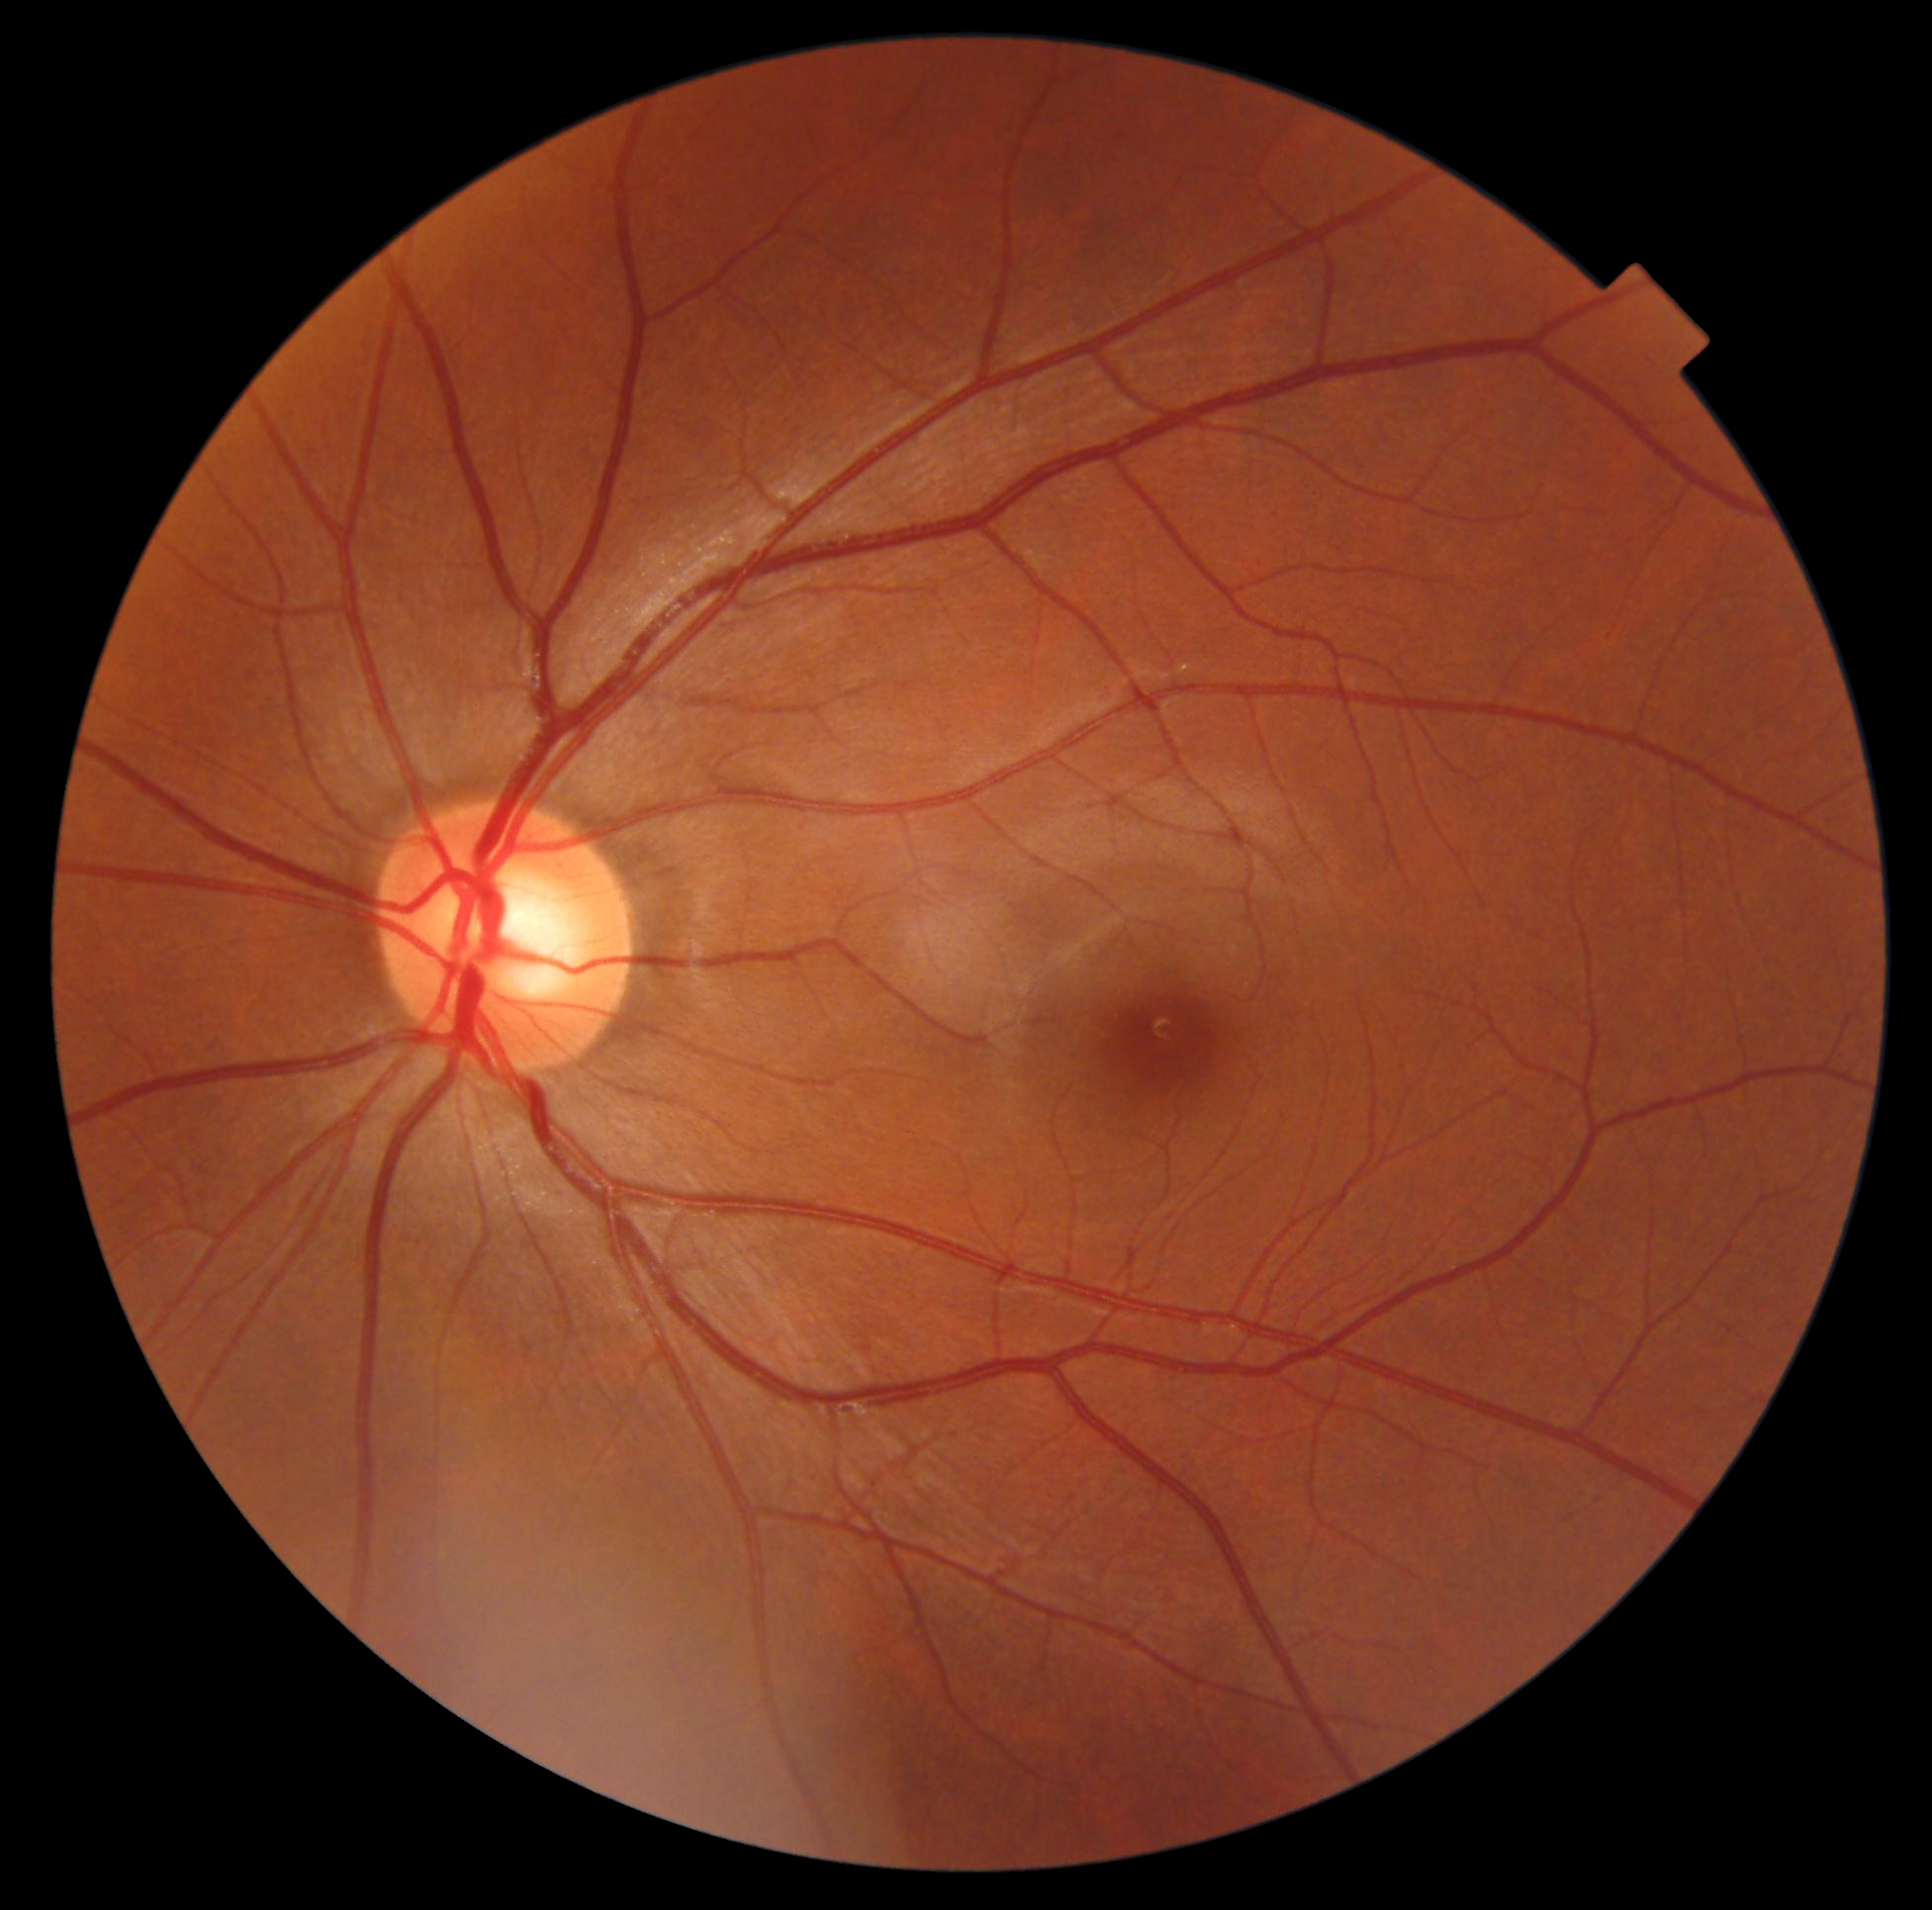
Diabetic retinopathy (DR) is 0/4.